45-degree field of view · 848x848px · fundus photo
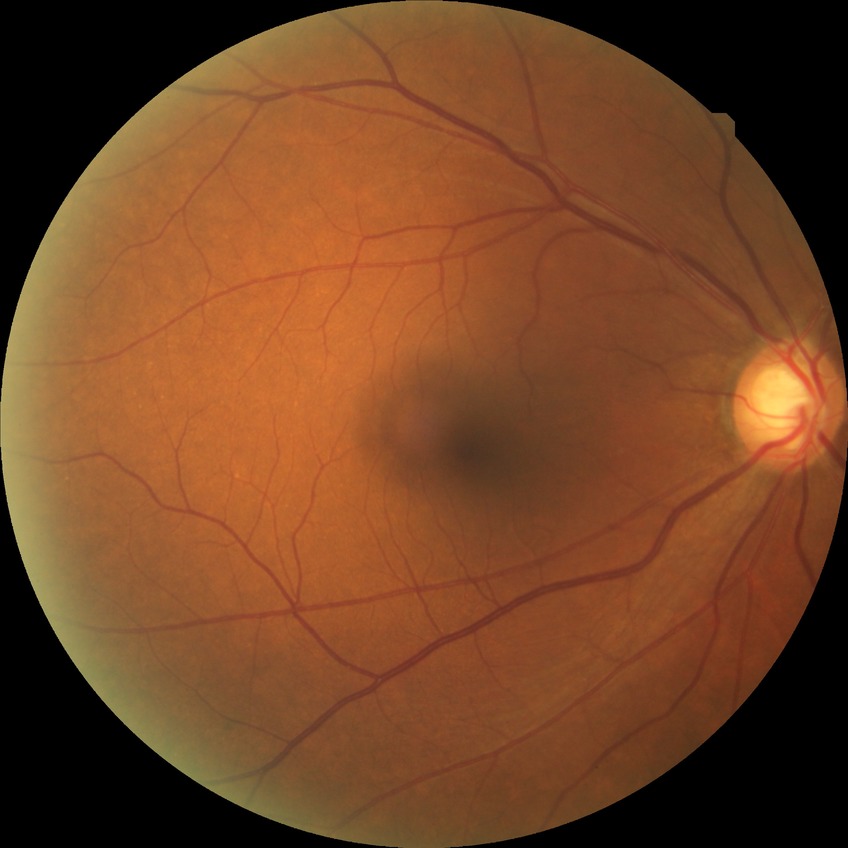

Diabetic retinopathy (DR) is NDR (no diabetic retinopathy).